Acquired with a NIDEK AFC-230. Nonmydriatic. 45-degree field of view
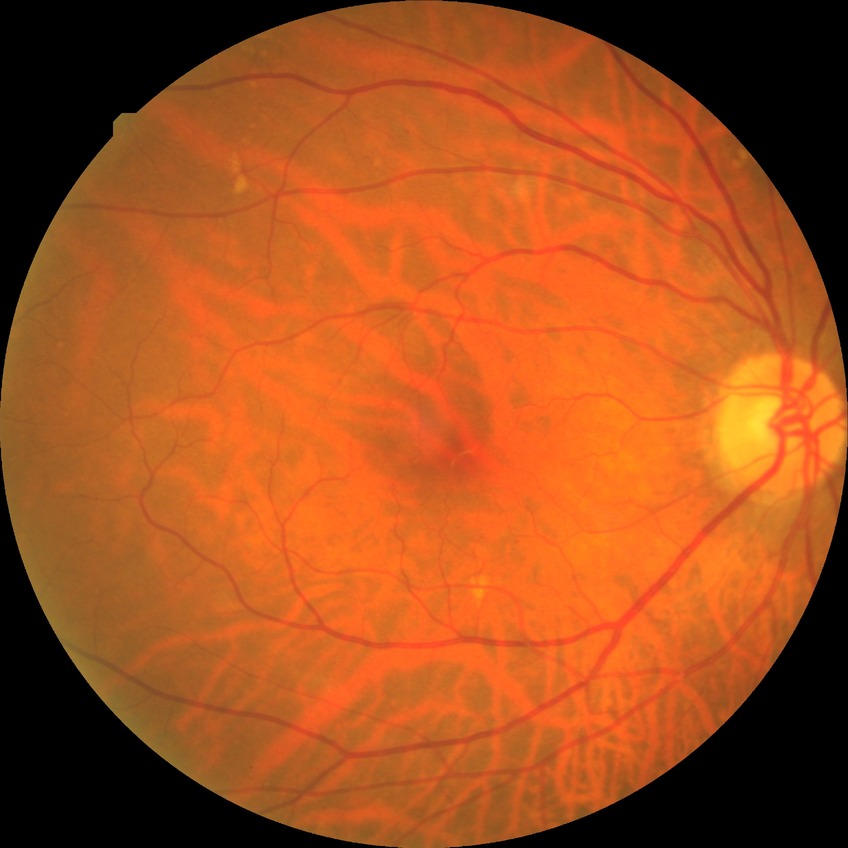

Modified Davis grading is no diabetic retinopathy.